Retinal fundus photograph
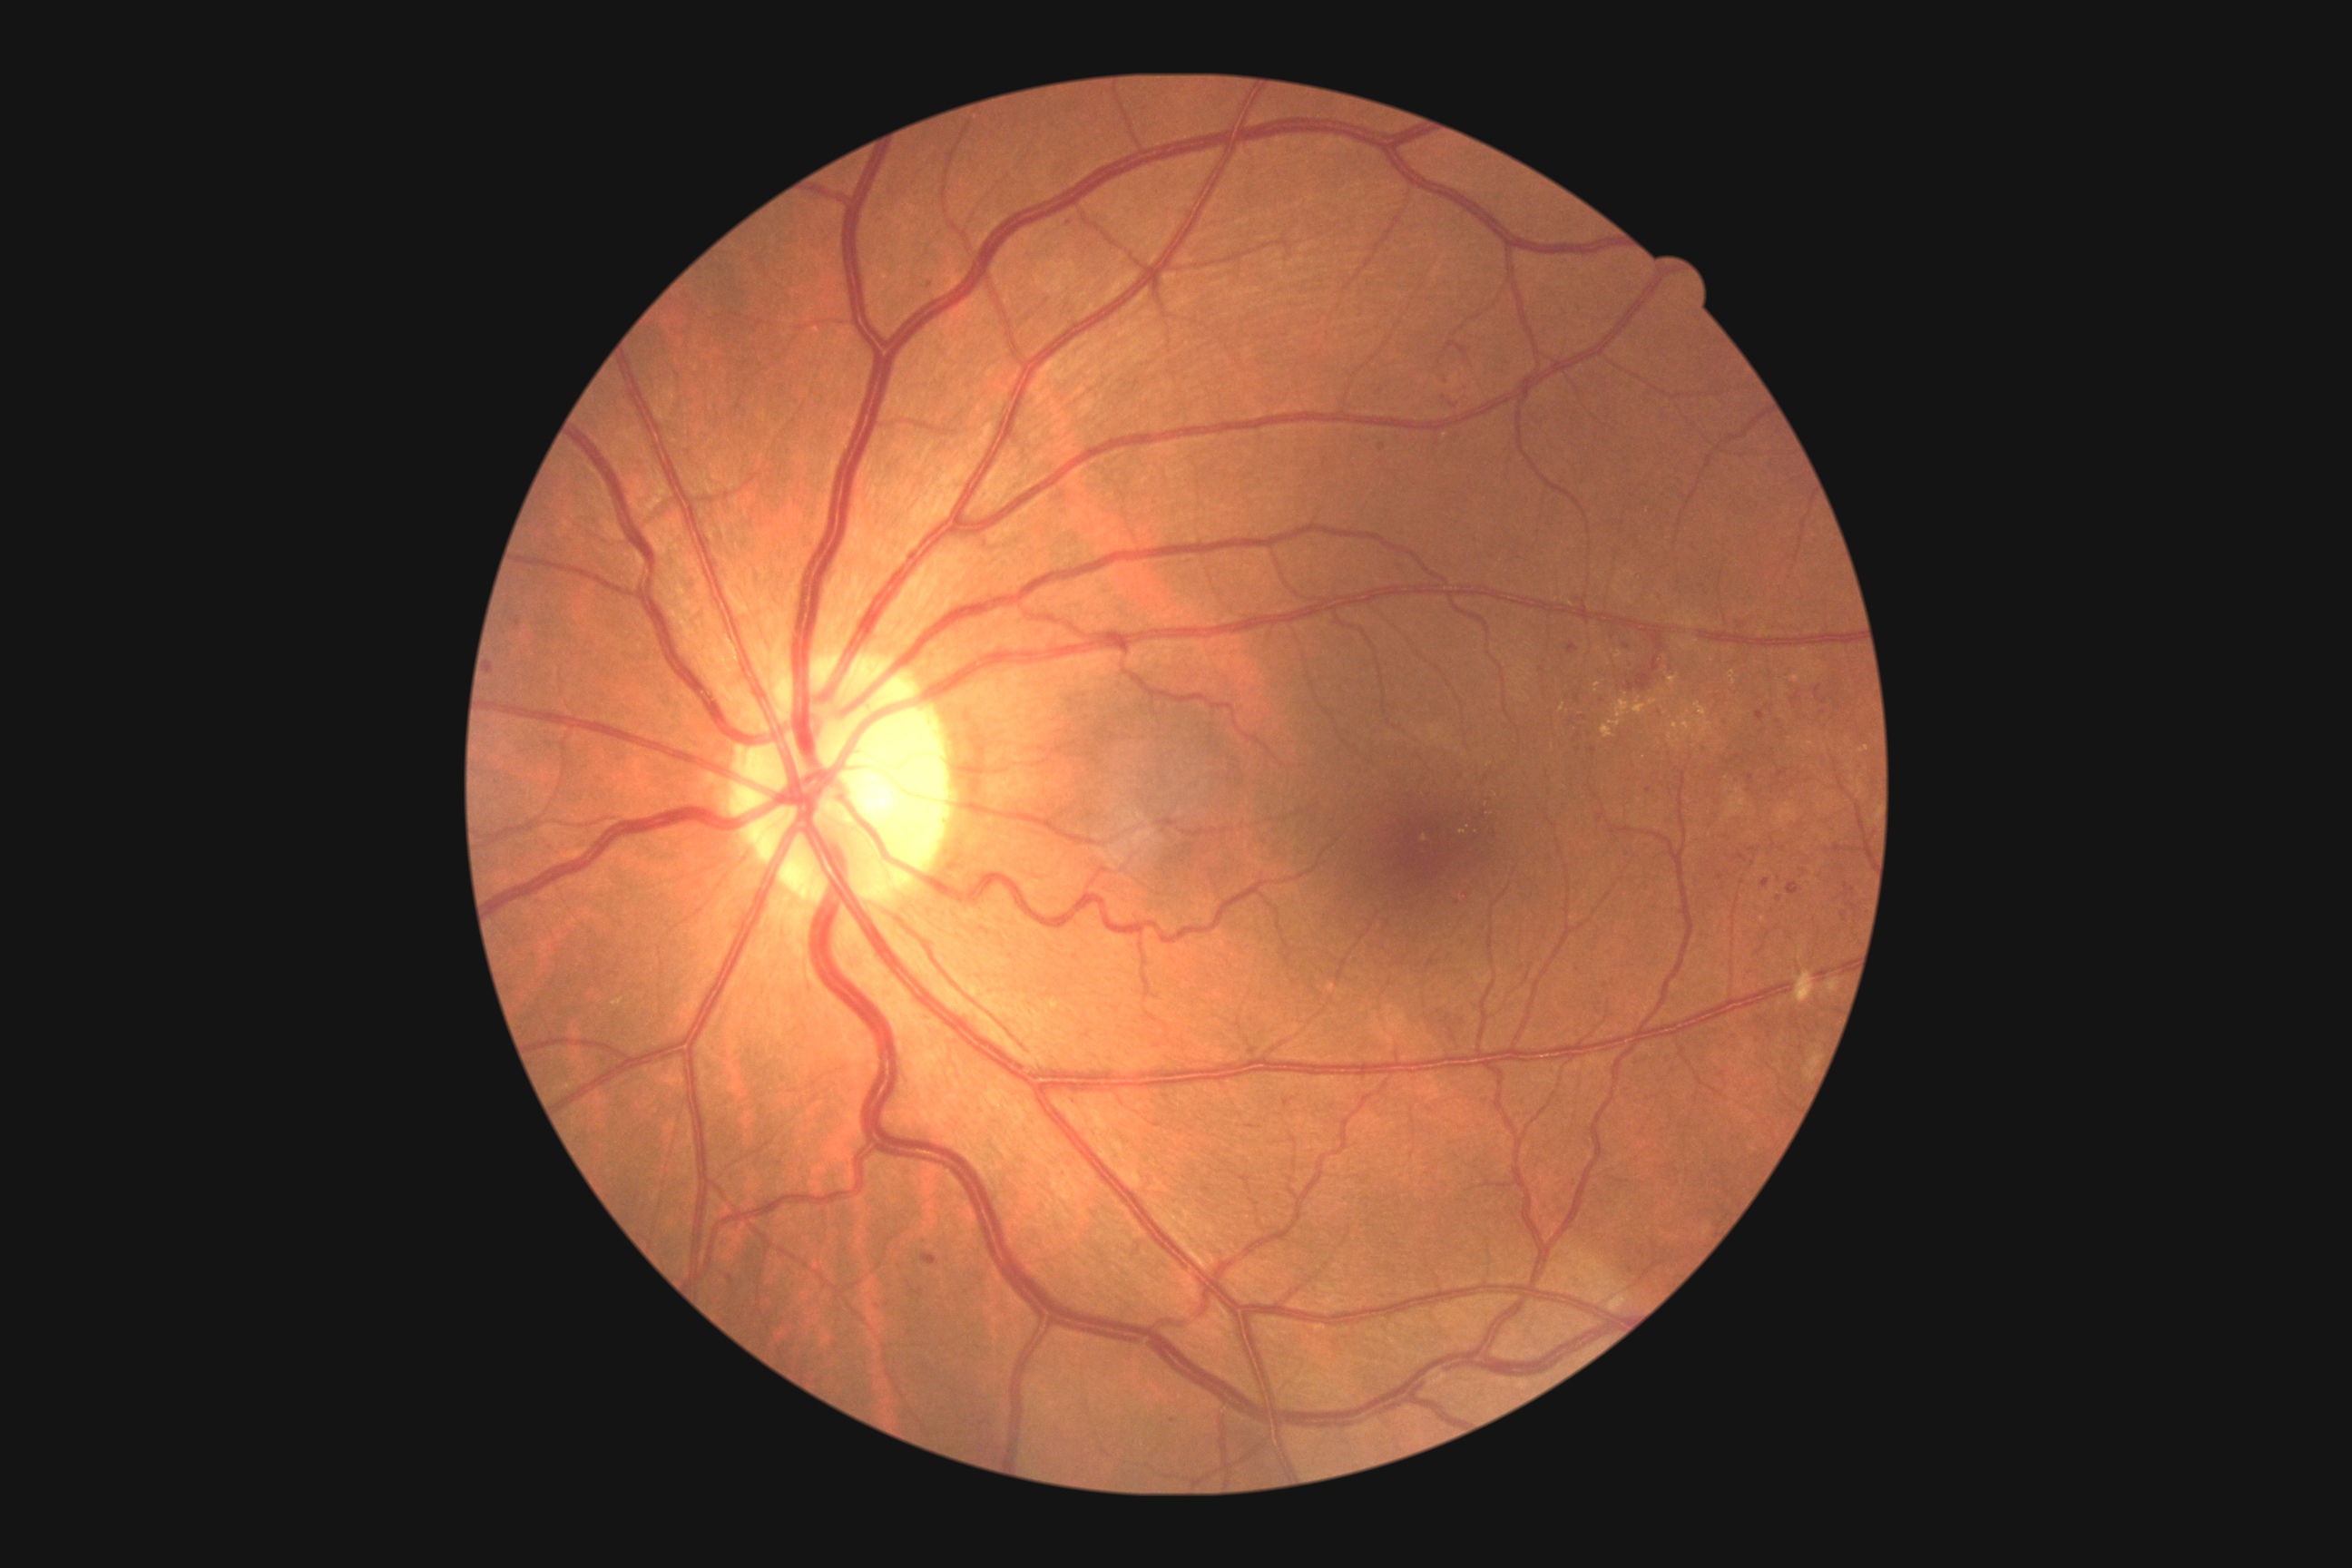

{"partial": true, "dr_grade": 2, "dr_grade_name": "moderate NPDR", "lesions": {"se": null, "ma": null, "ex": [[1696, 703, 1714, 740], [1649, 700, 1658, 705], [1667, 676, 1678, 687], [1672, 723, 1680, 732], [1632, 700, 1647, 716], [1458, 830, 1467, 836], [1729, 671, 1736, 685], [1614, 651, 1623, 660]], "ex_small": [[1825, 748], [1670, 737], [1687, 715], [1609, 665]], "he": [[1763, 877, 1770, 888], [1701, 747, 1709, 756], [1765, 703, 1776, 712], [1567, 645, 1578, 654], [1721, 720, 1732, 730], [1578, 716, 1589, 723], [489, 663, 493, 674], [1843, 885, 1856, 899], [874, 1300, 885, 1313], [1602, 627, 1680, 694], [727, 1275, 732, 1284]], "he_small": [[1628, 648], [1144, 109], [1804, 873], [1750, 778], [1752, 850]]}}